Wide-field fundus photograph from neonatal ROP screening — 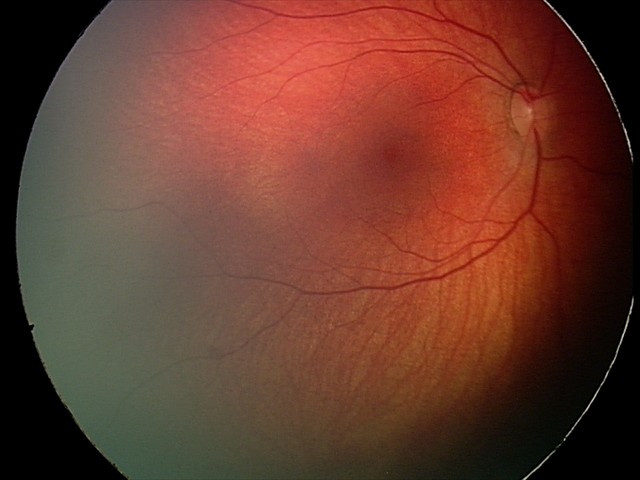 Screening diagnosis = retinal hemorrhages